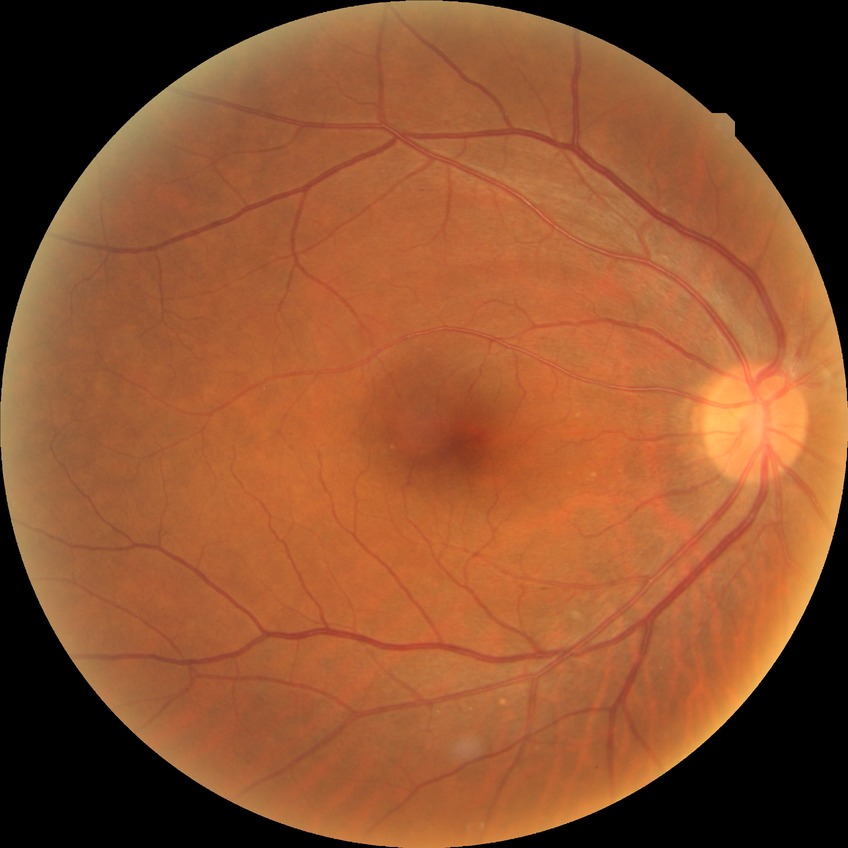

Davis grading: no diabetic retinopathy.